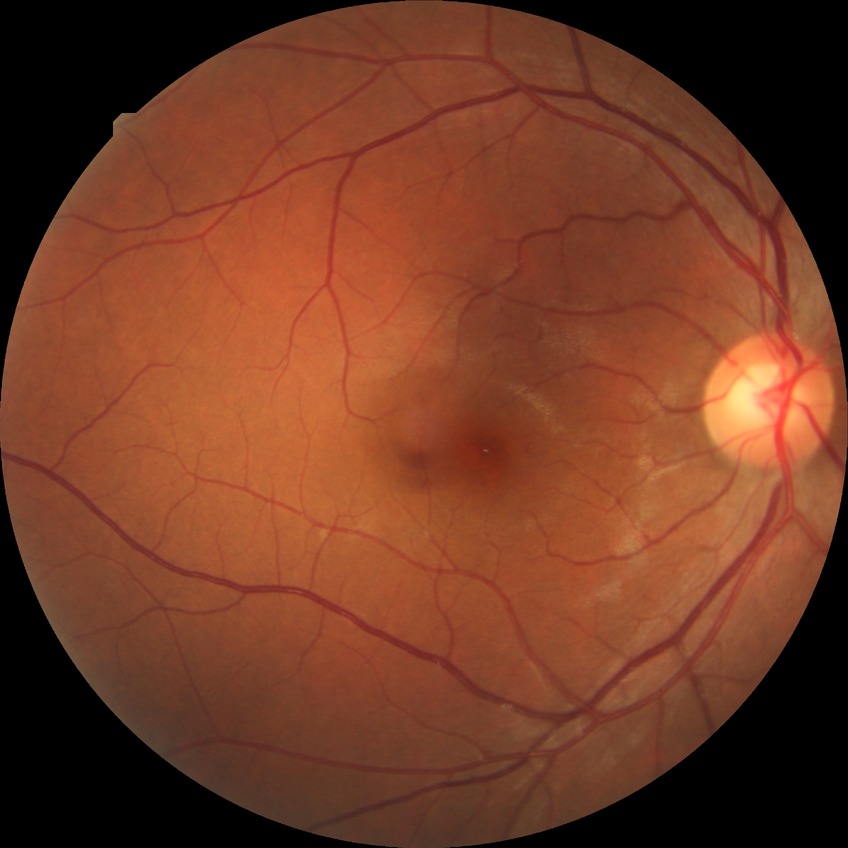

Diabetic retinopathy (DR) is SDR (simple diabetic retinopathy).